Optic nerve head photograph · Topcon TRC fundus camera · image size 331x331
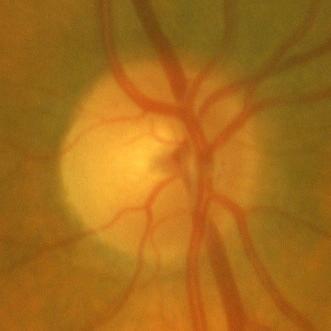 Assessment = no glaucomatous damage.